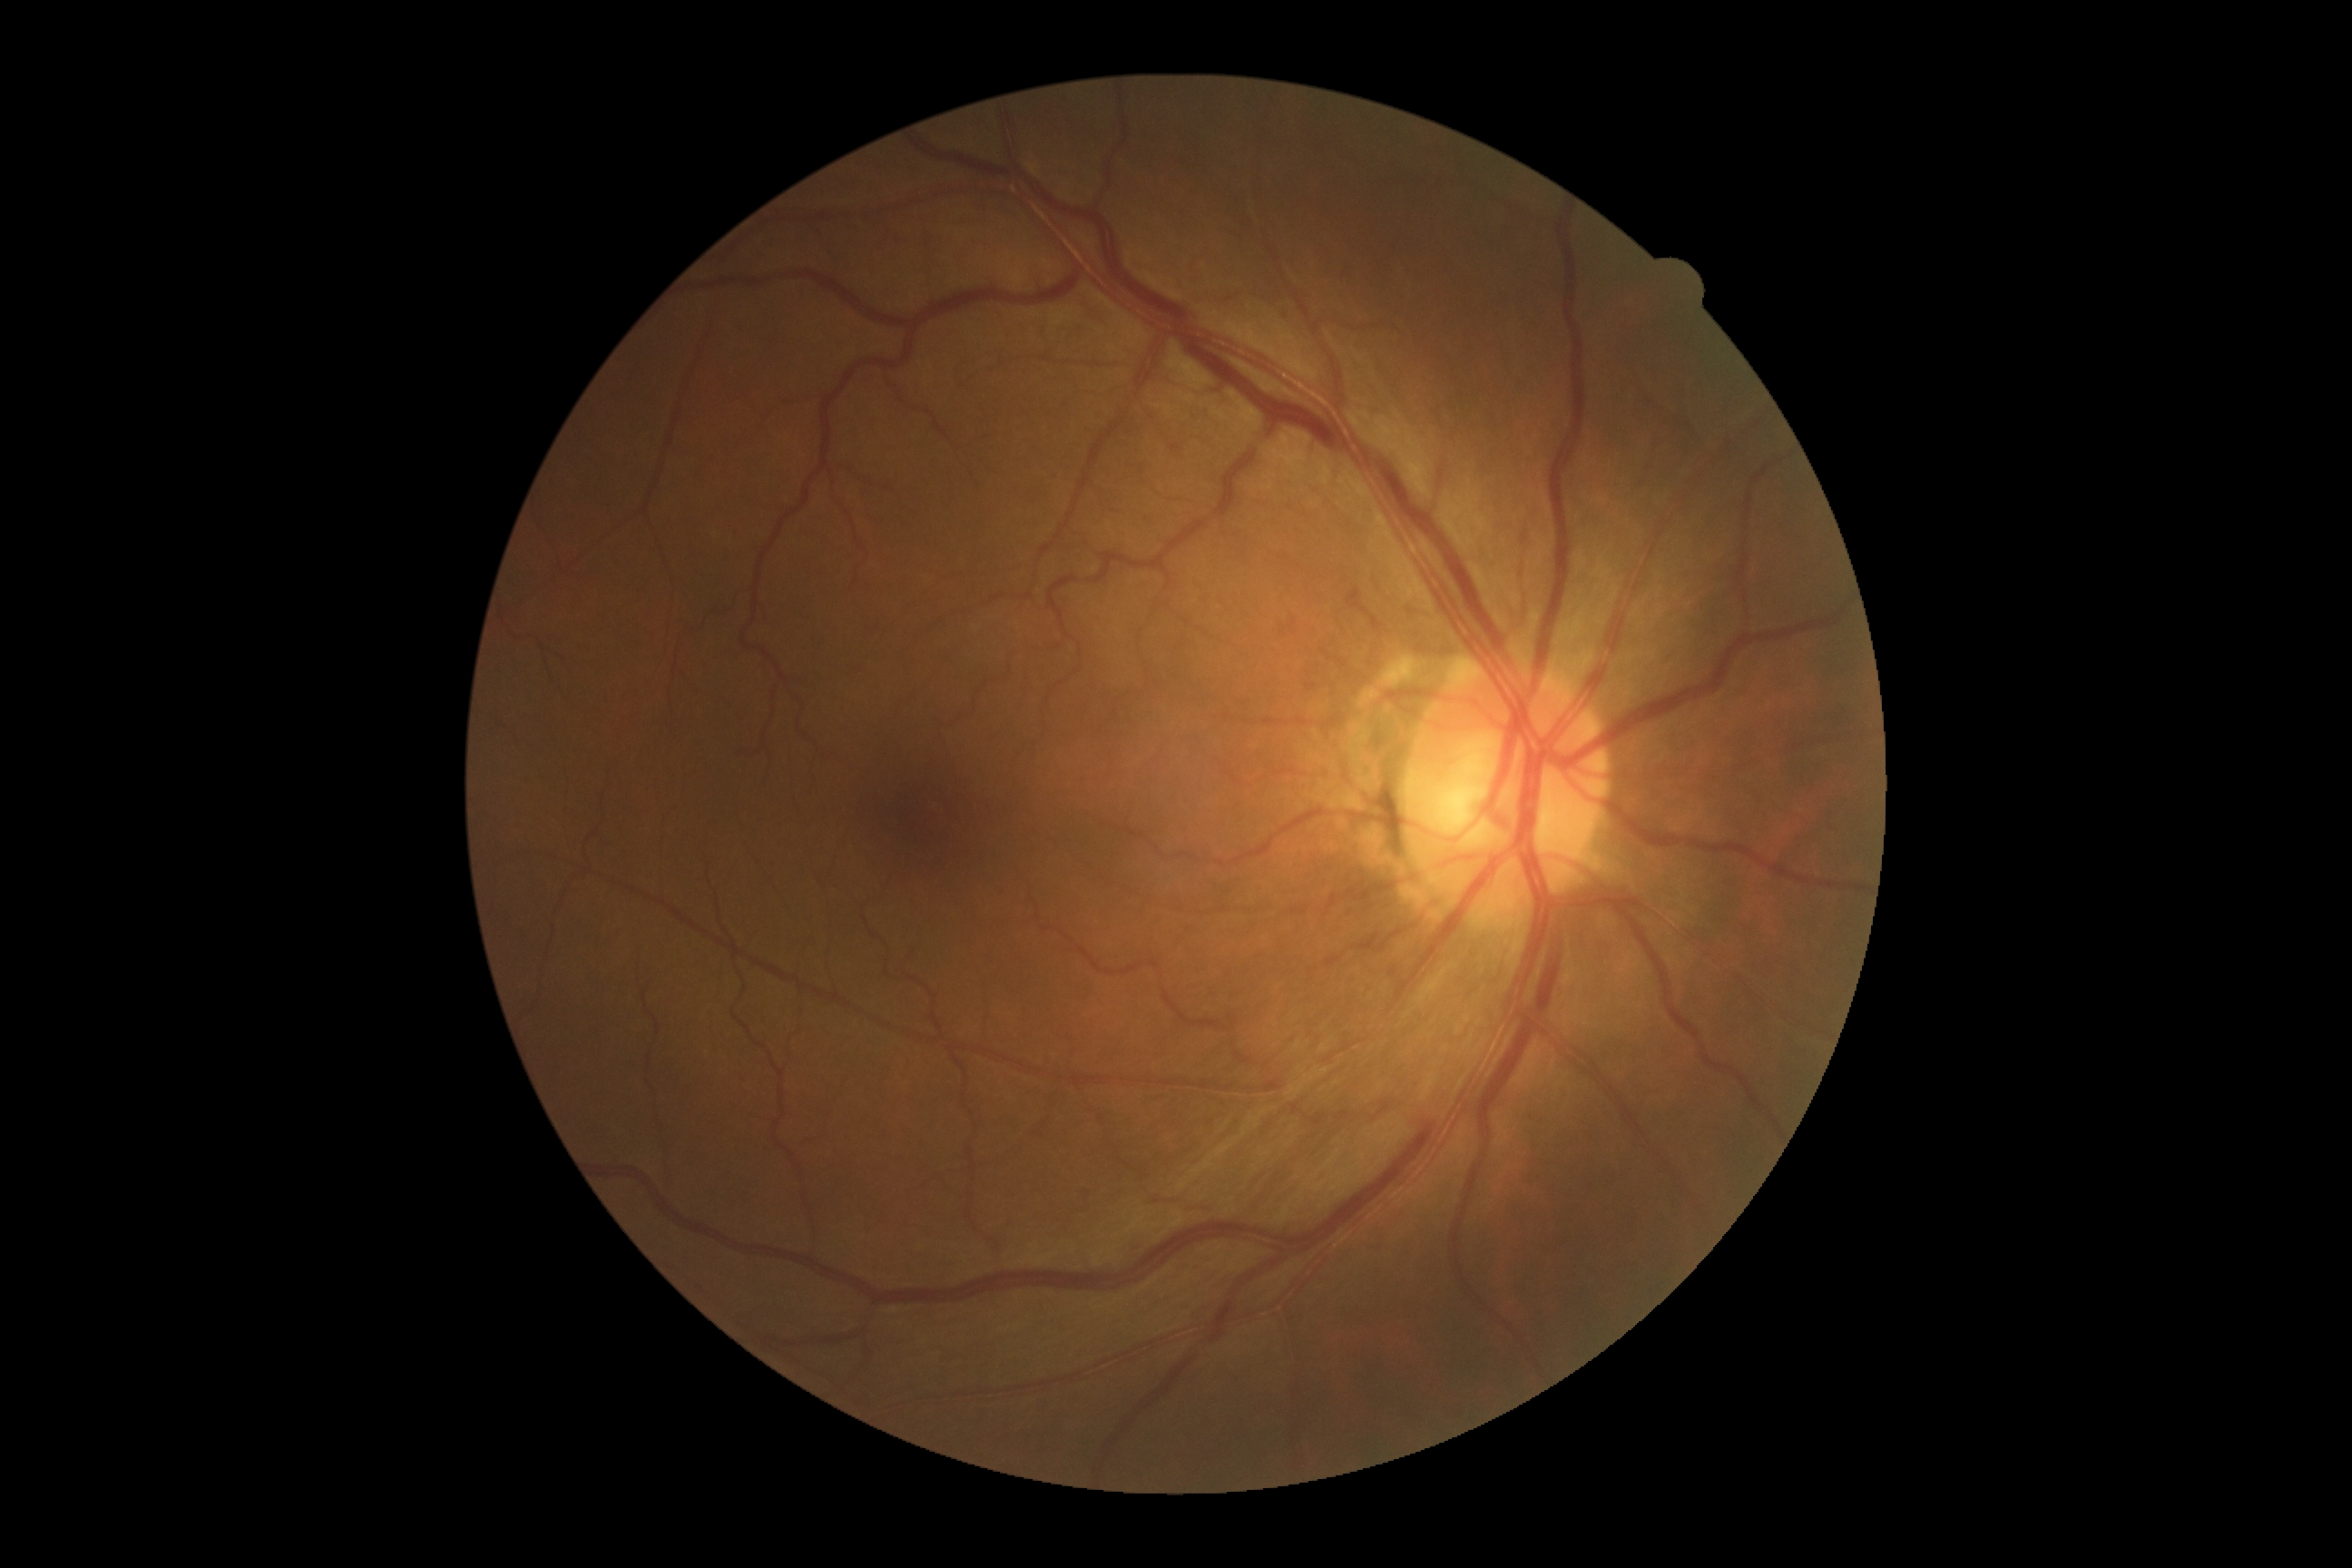

DR impression@negative for DR; diabetic retinopathy severity@grade 0.